Infant wide-field fundus photograph; 640x480
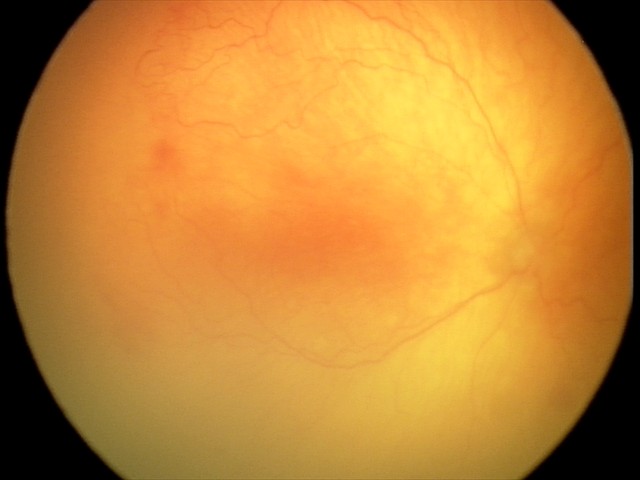
Plus disease present. Examination diagnosed as A-ROP (aggressive ROP).